FOV: 50 degrees
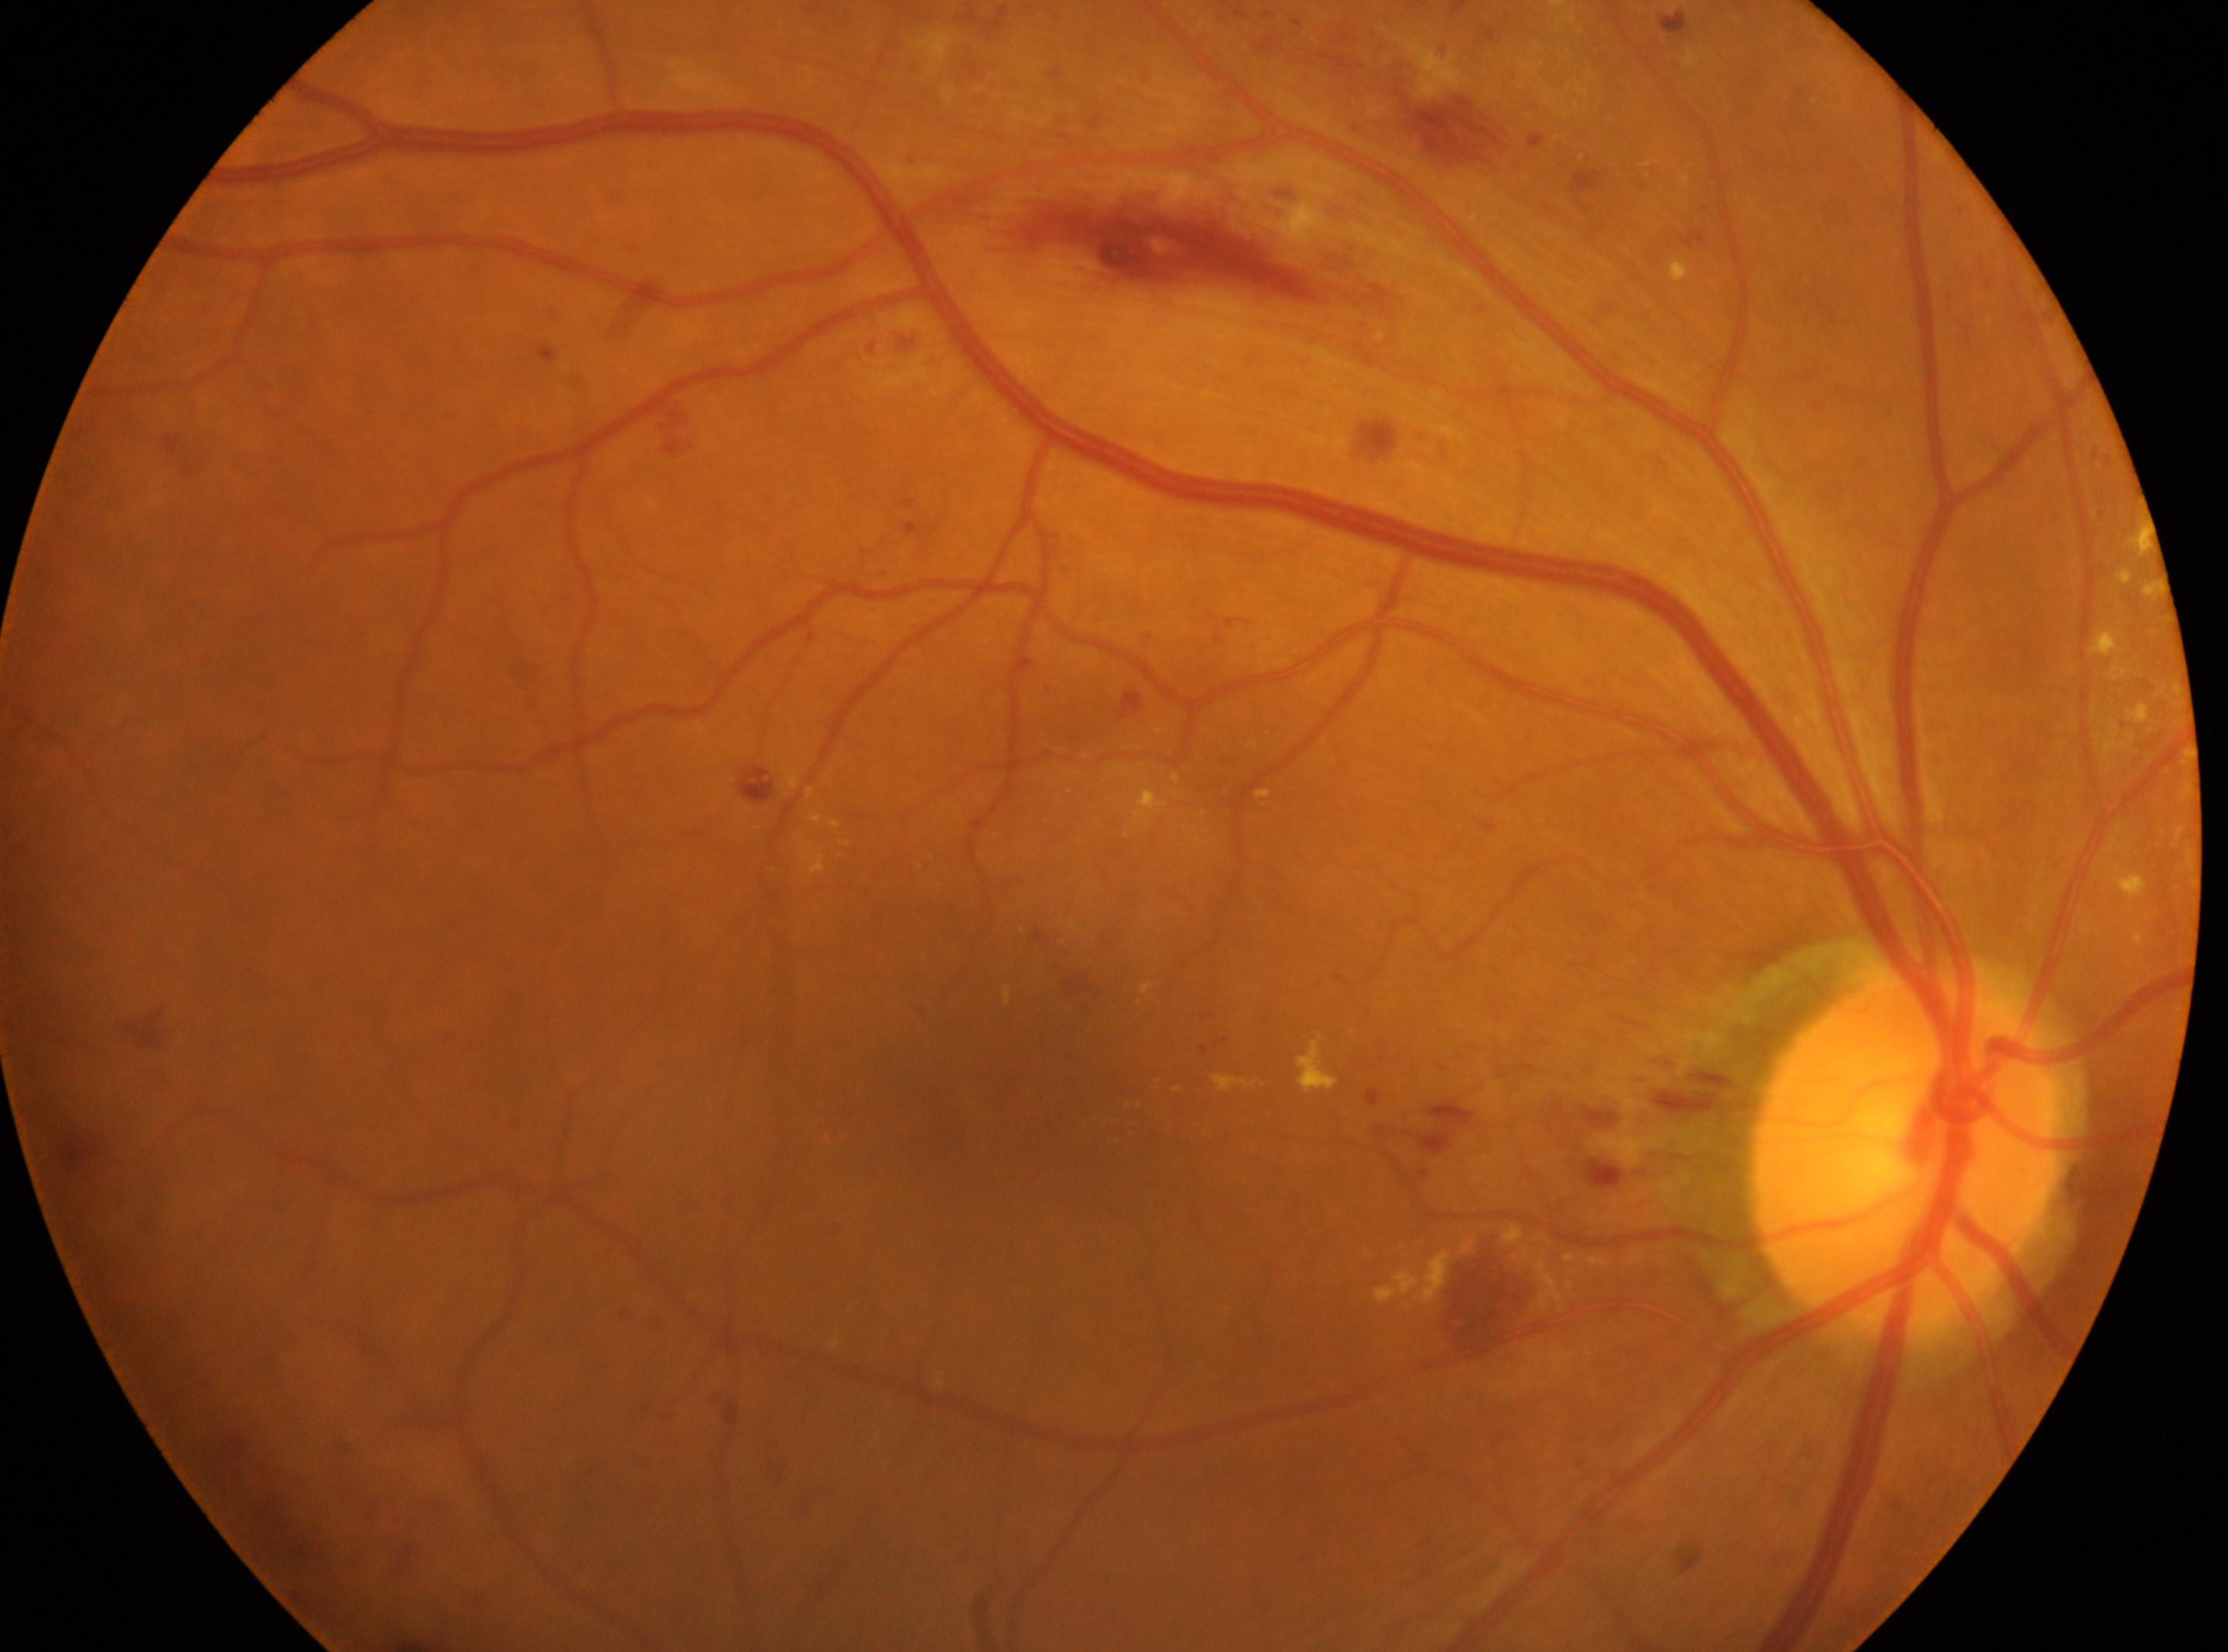
The image shows the OD.
Disc center: 1902, 1152.
Retinopathy: moderate NPDR (grade 2).
DR class: non-proliferative diabetic retinopathy.
Fovea located at 1020, 1072.